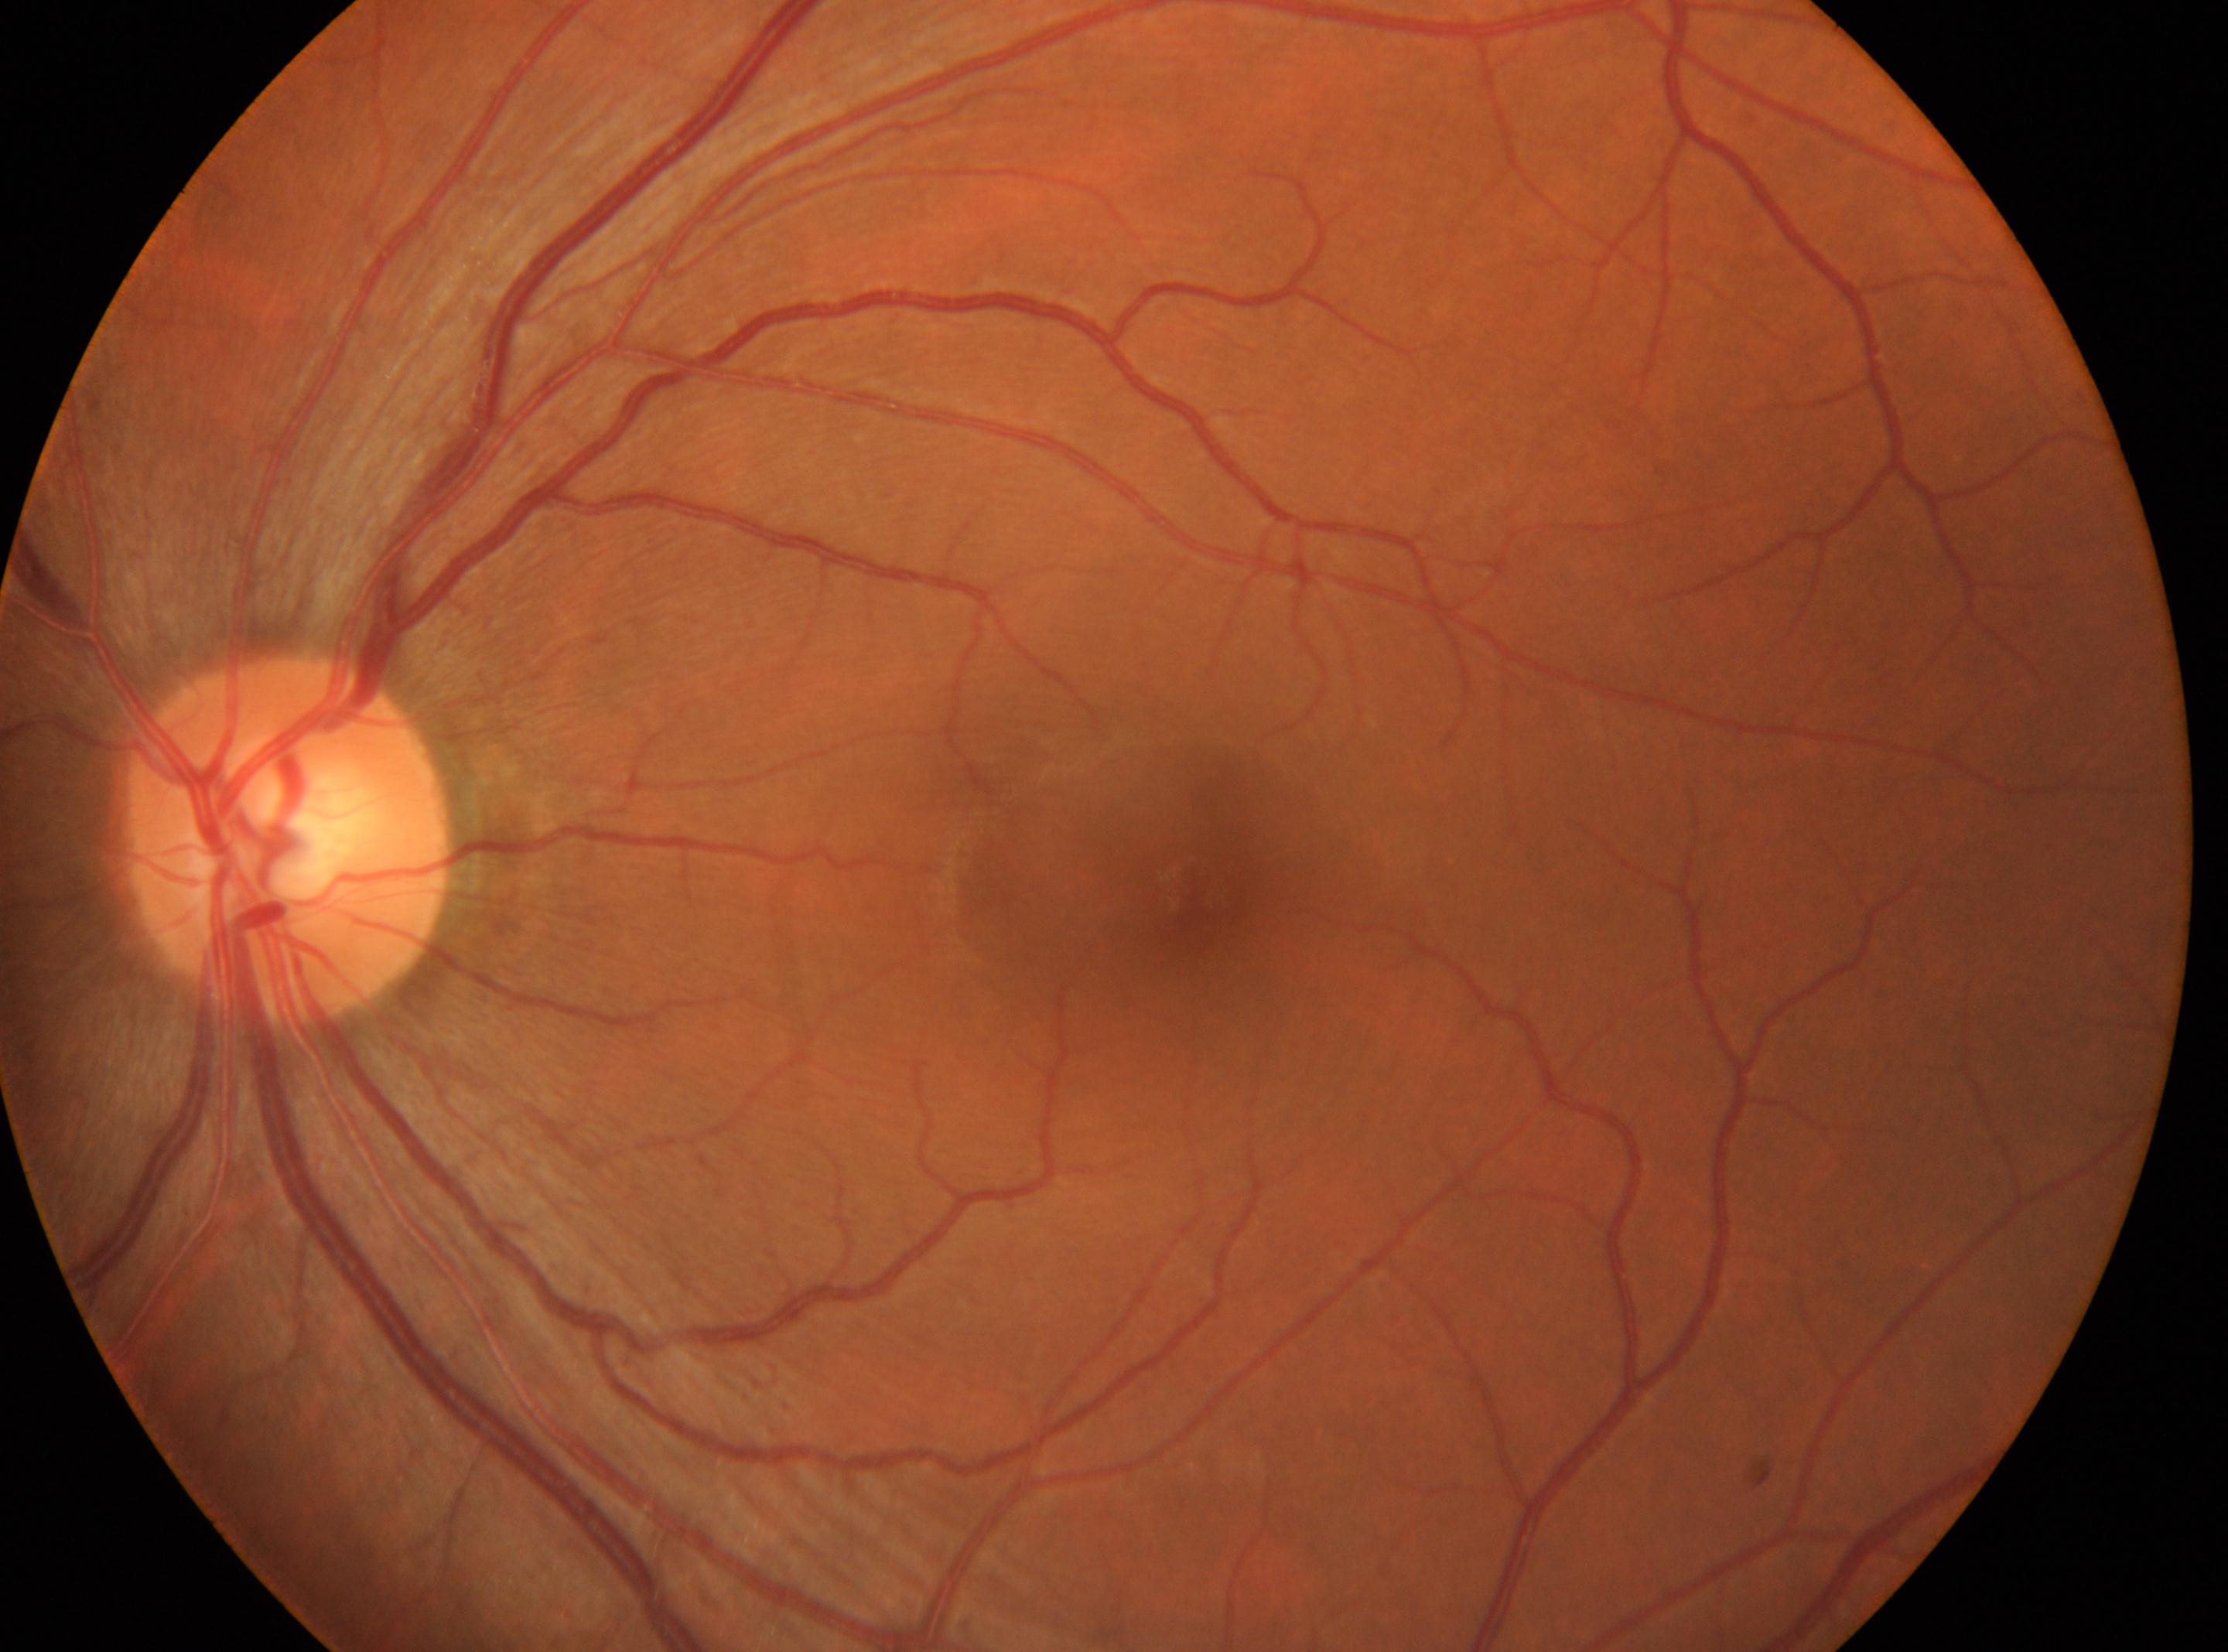 fovea@(x: 1191, y: 885); retinopathy grade@no apparent diabetic retinopathy (0); left eye; optic disc@(x: 288, y: 841).